Optic disc region crop.
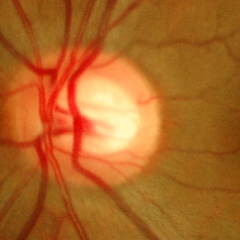

Q: What stage of glaucoma is present?
A: No glaucoma.